Retinal fundus photograph. 848x848. DR severity per modified Davis staging: 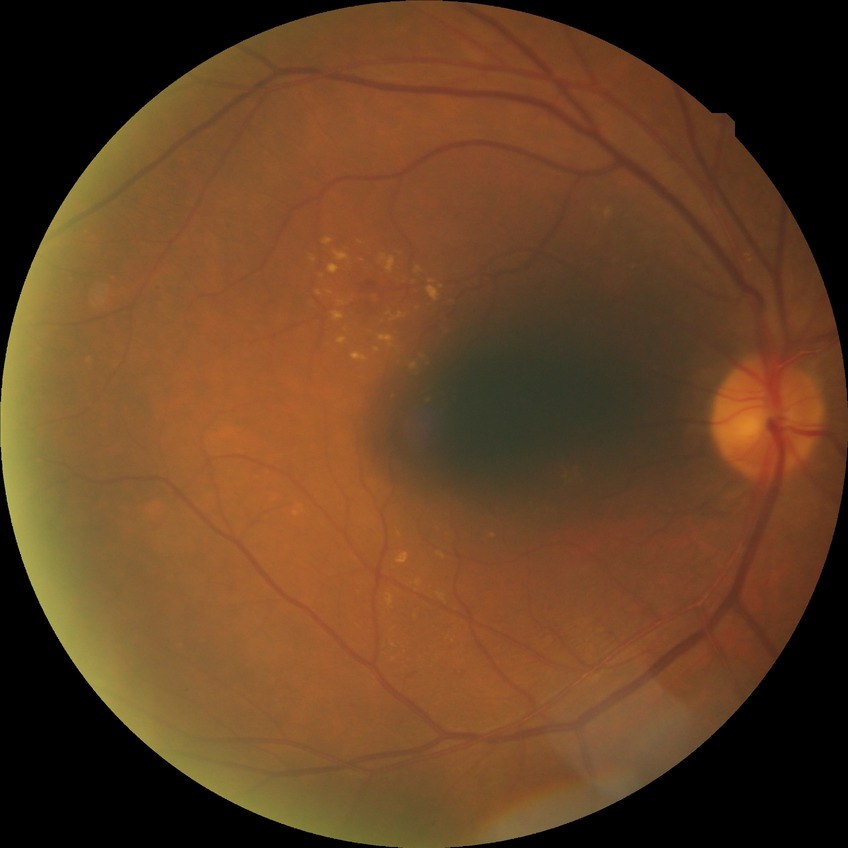

Retinopathy grade is simple diabetic retinopathy.